Camera: NIDEK AFC-230.
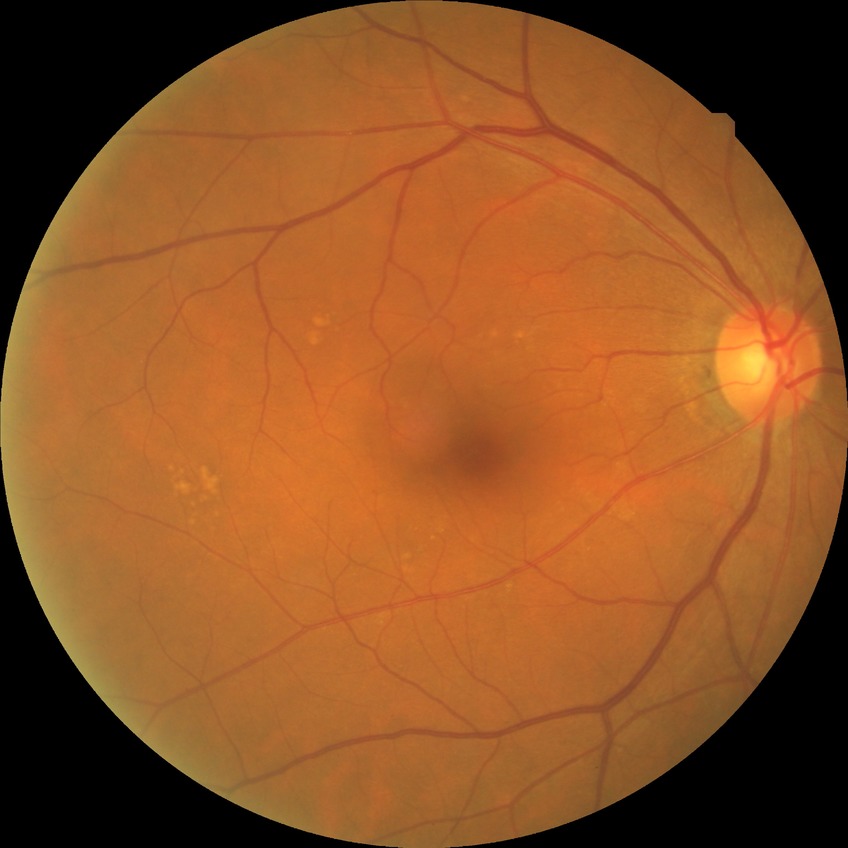

Diabetic retinopathy (DR): no diabetic retinopathy (NDR).